45° FOV.
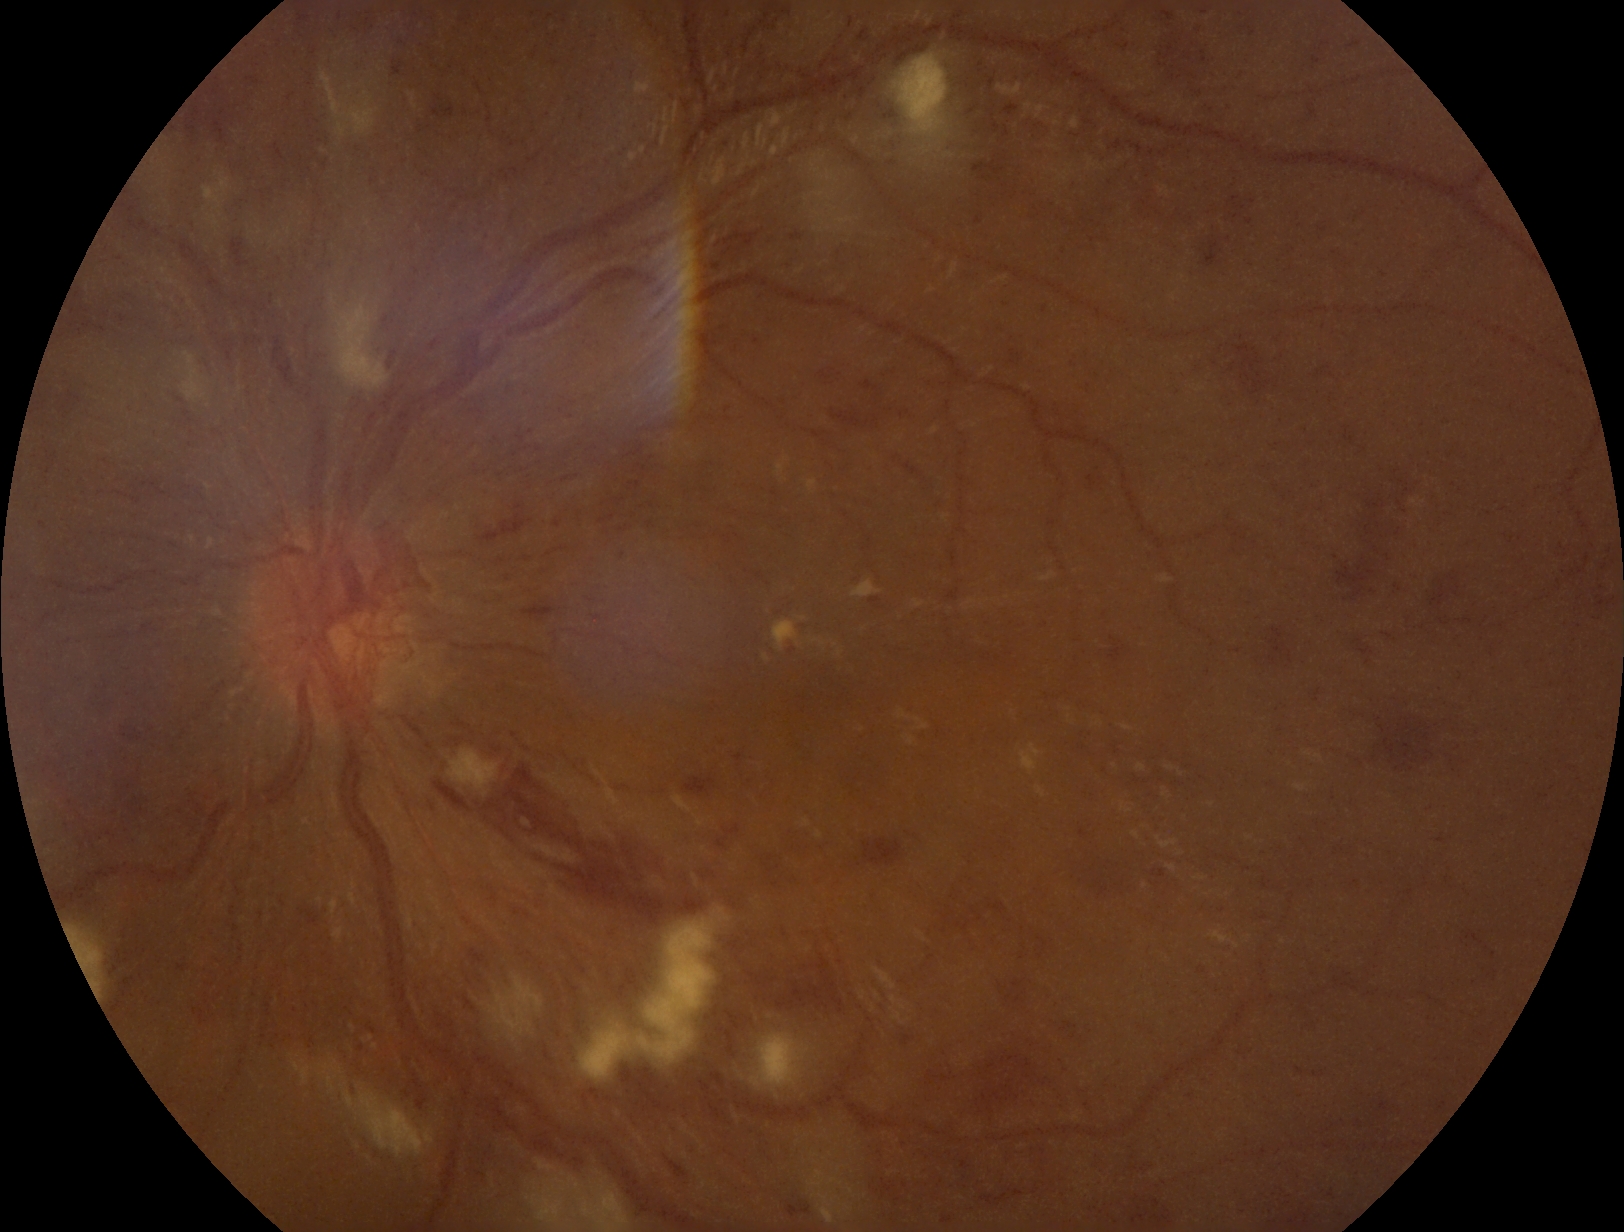 Diabetic retinopathy (DR): grade 4 (PDR).